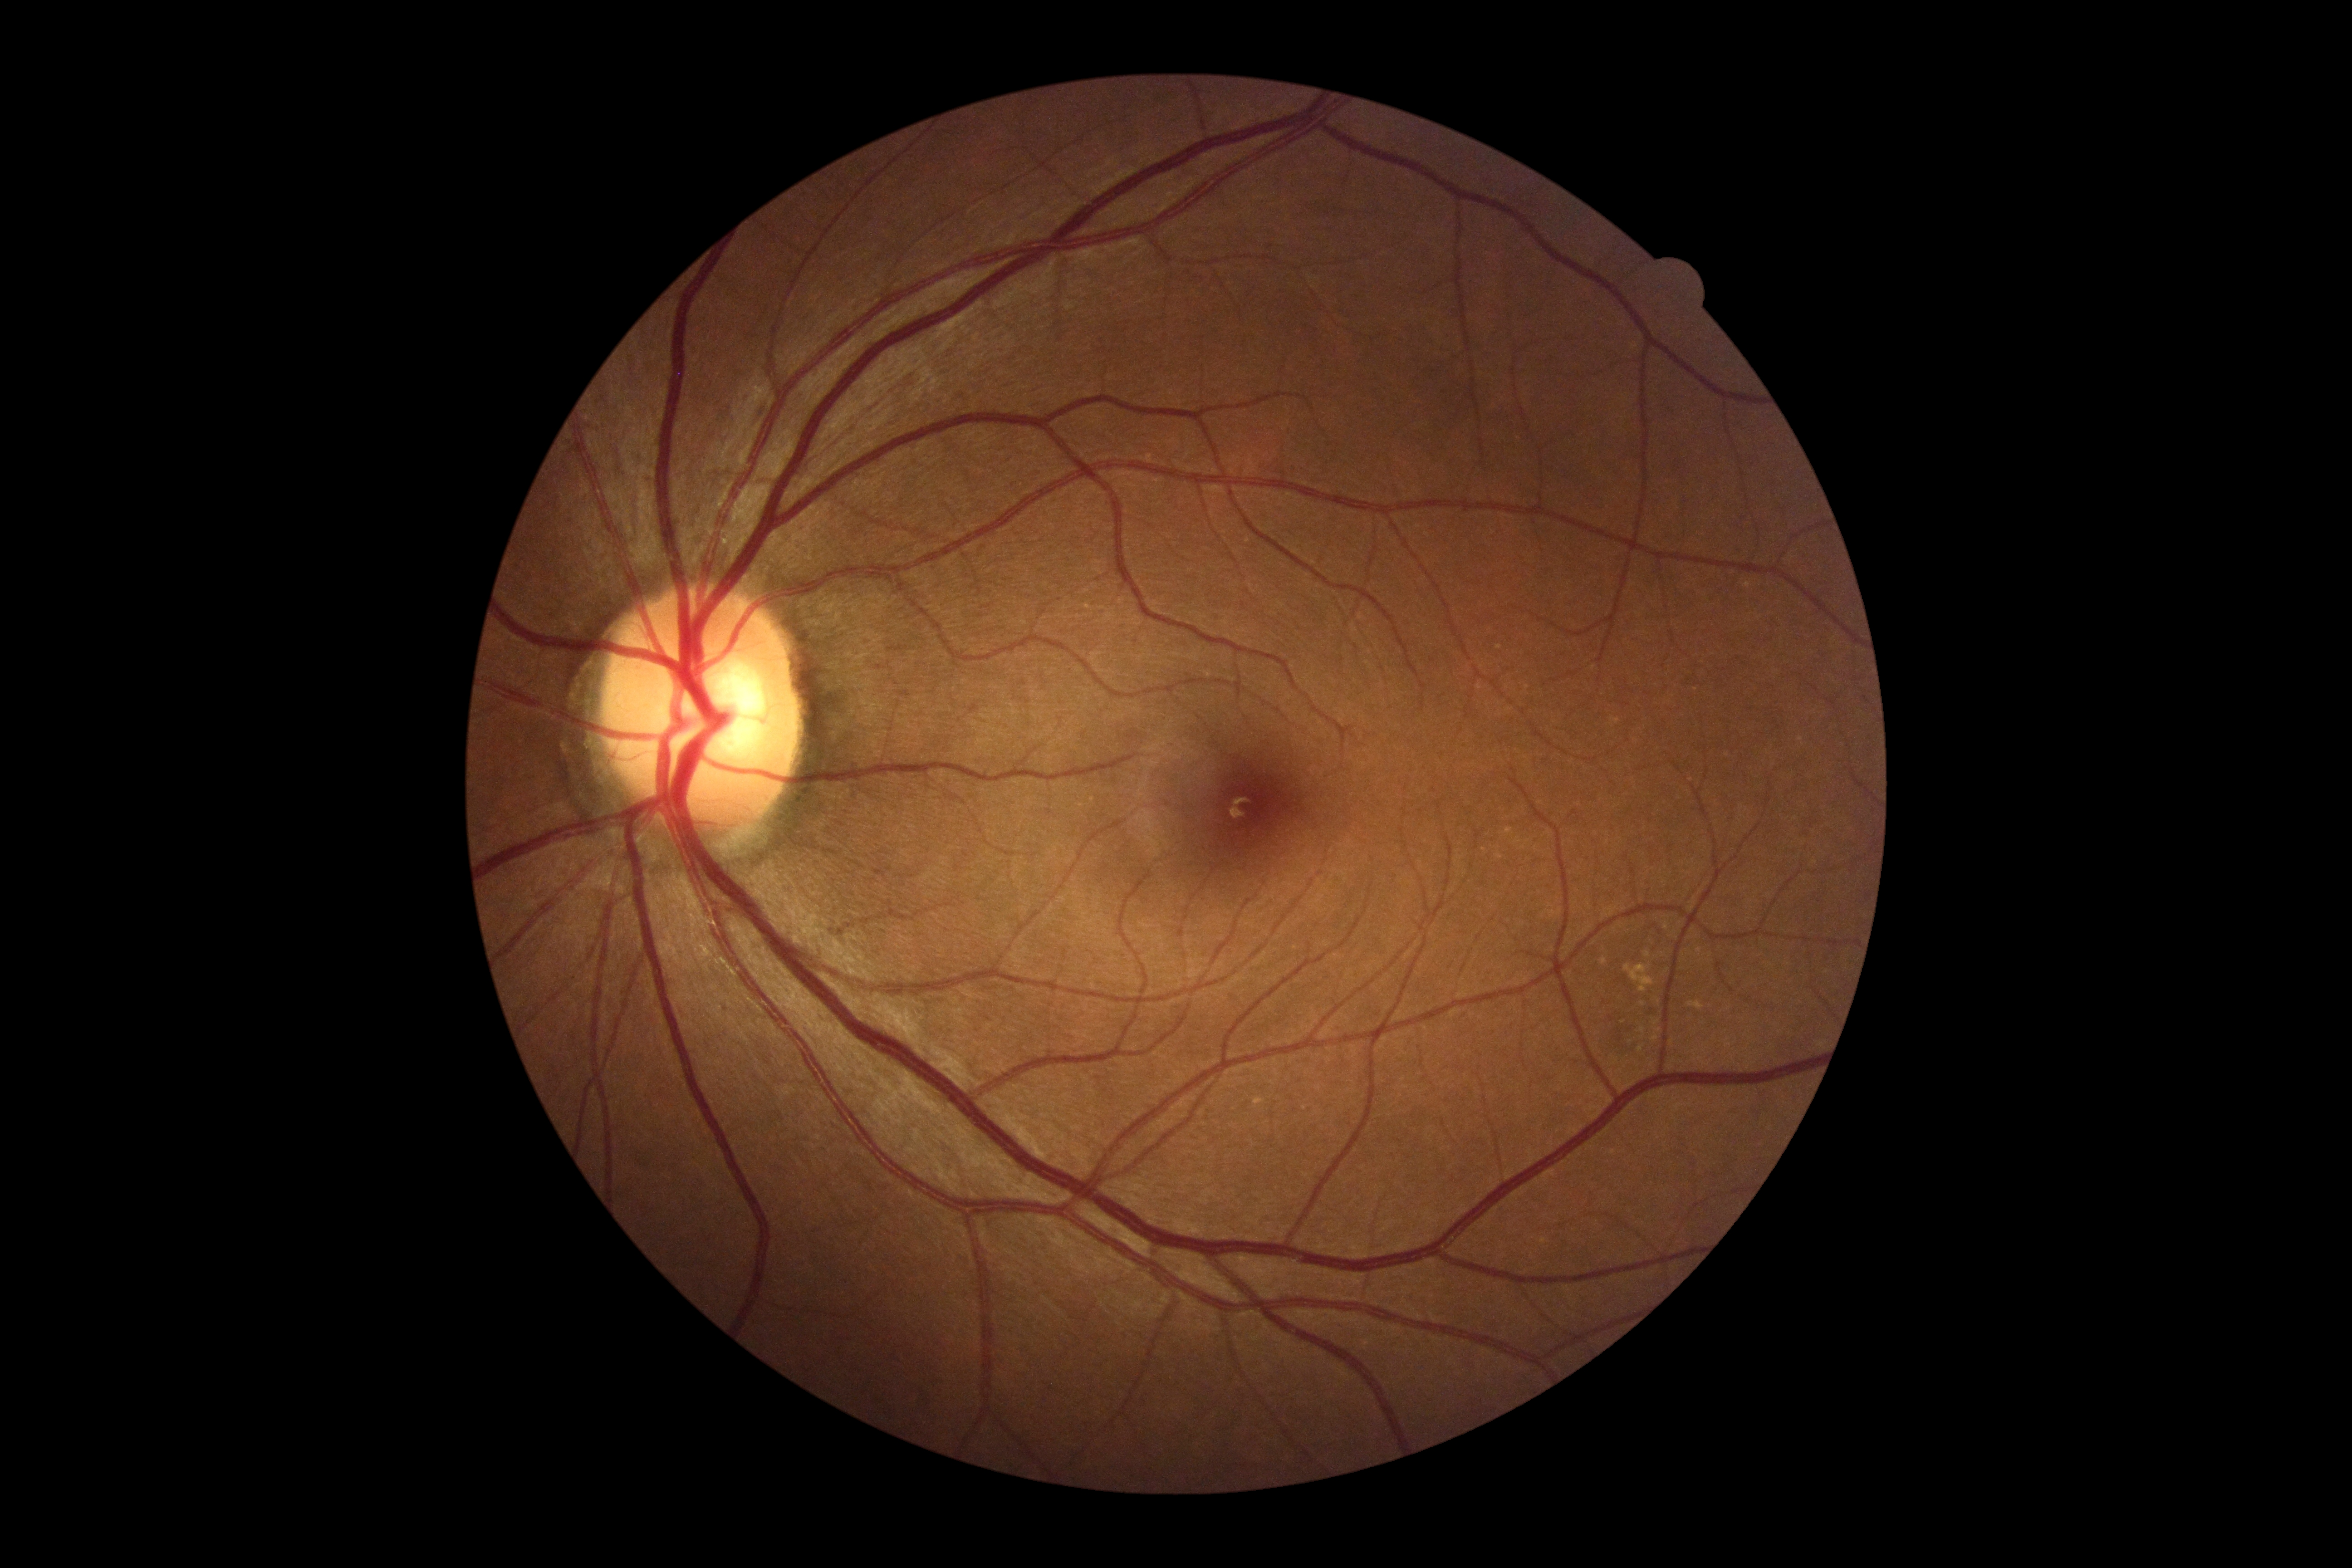

diabetic retinopathy (DR) = 0.